Infant wide-field fundus photograph; 640 by 480 pixels:
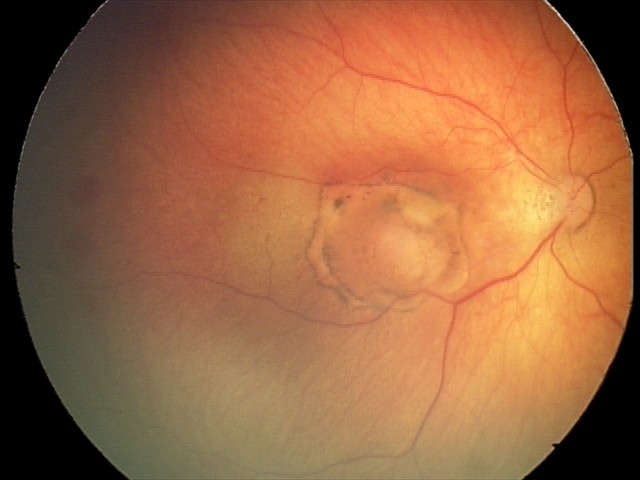 Screening examination consistent with toxoplasmosis chorioretinitis.